Retinal fundus photograph
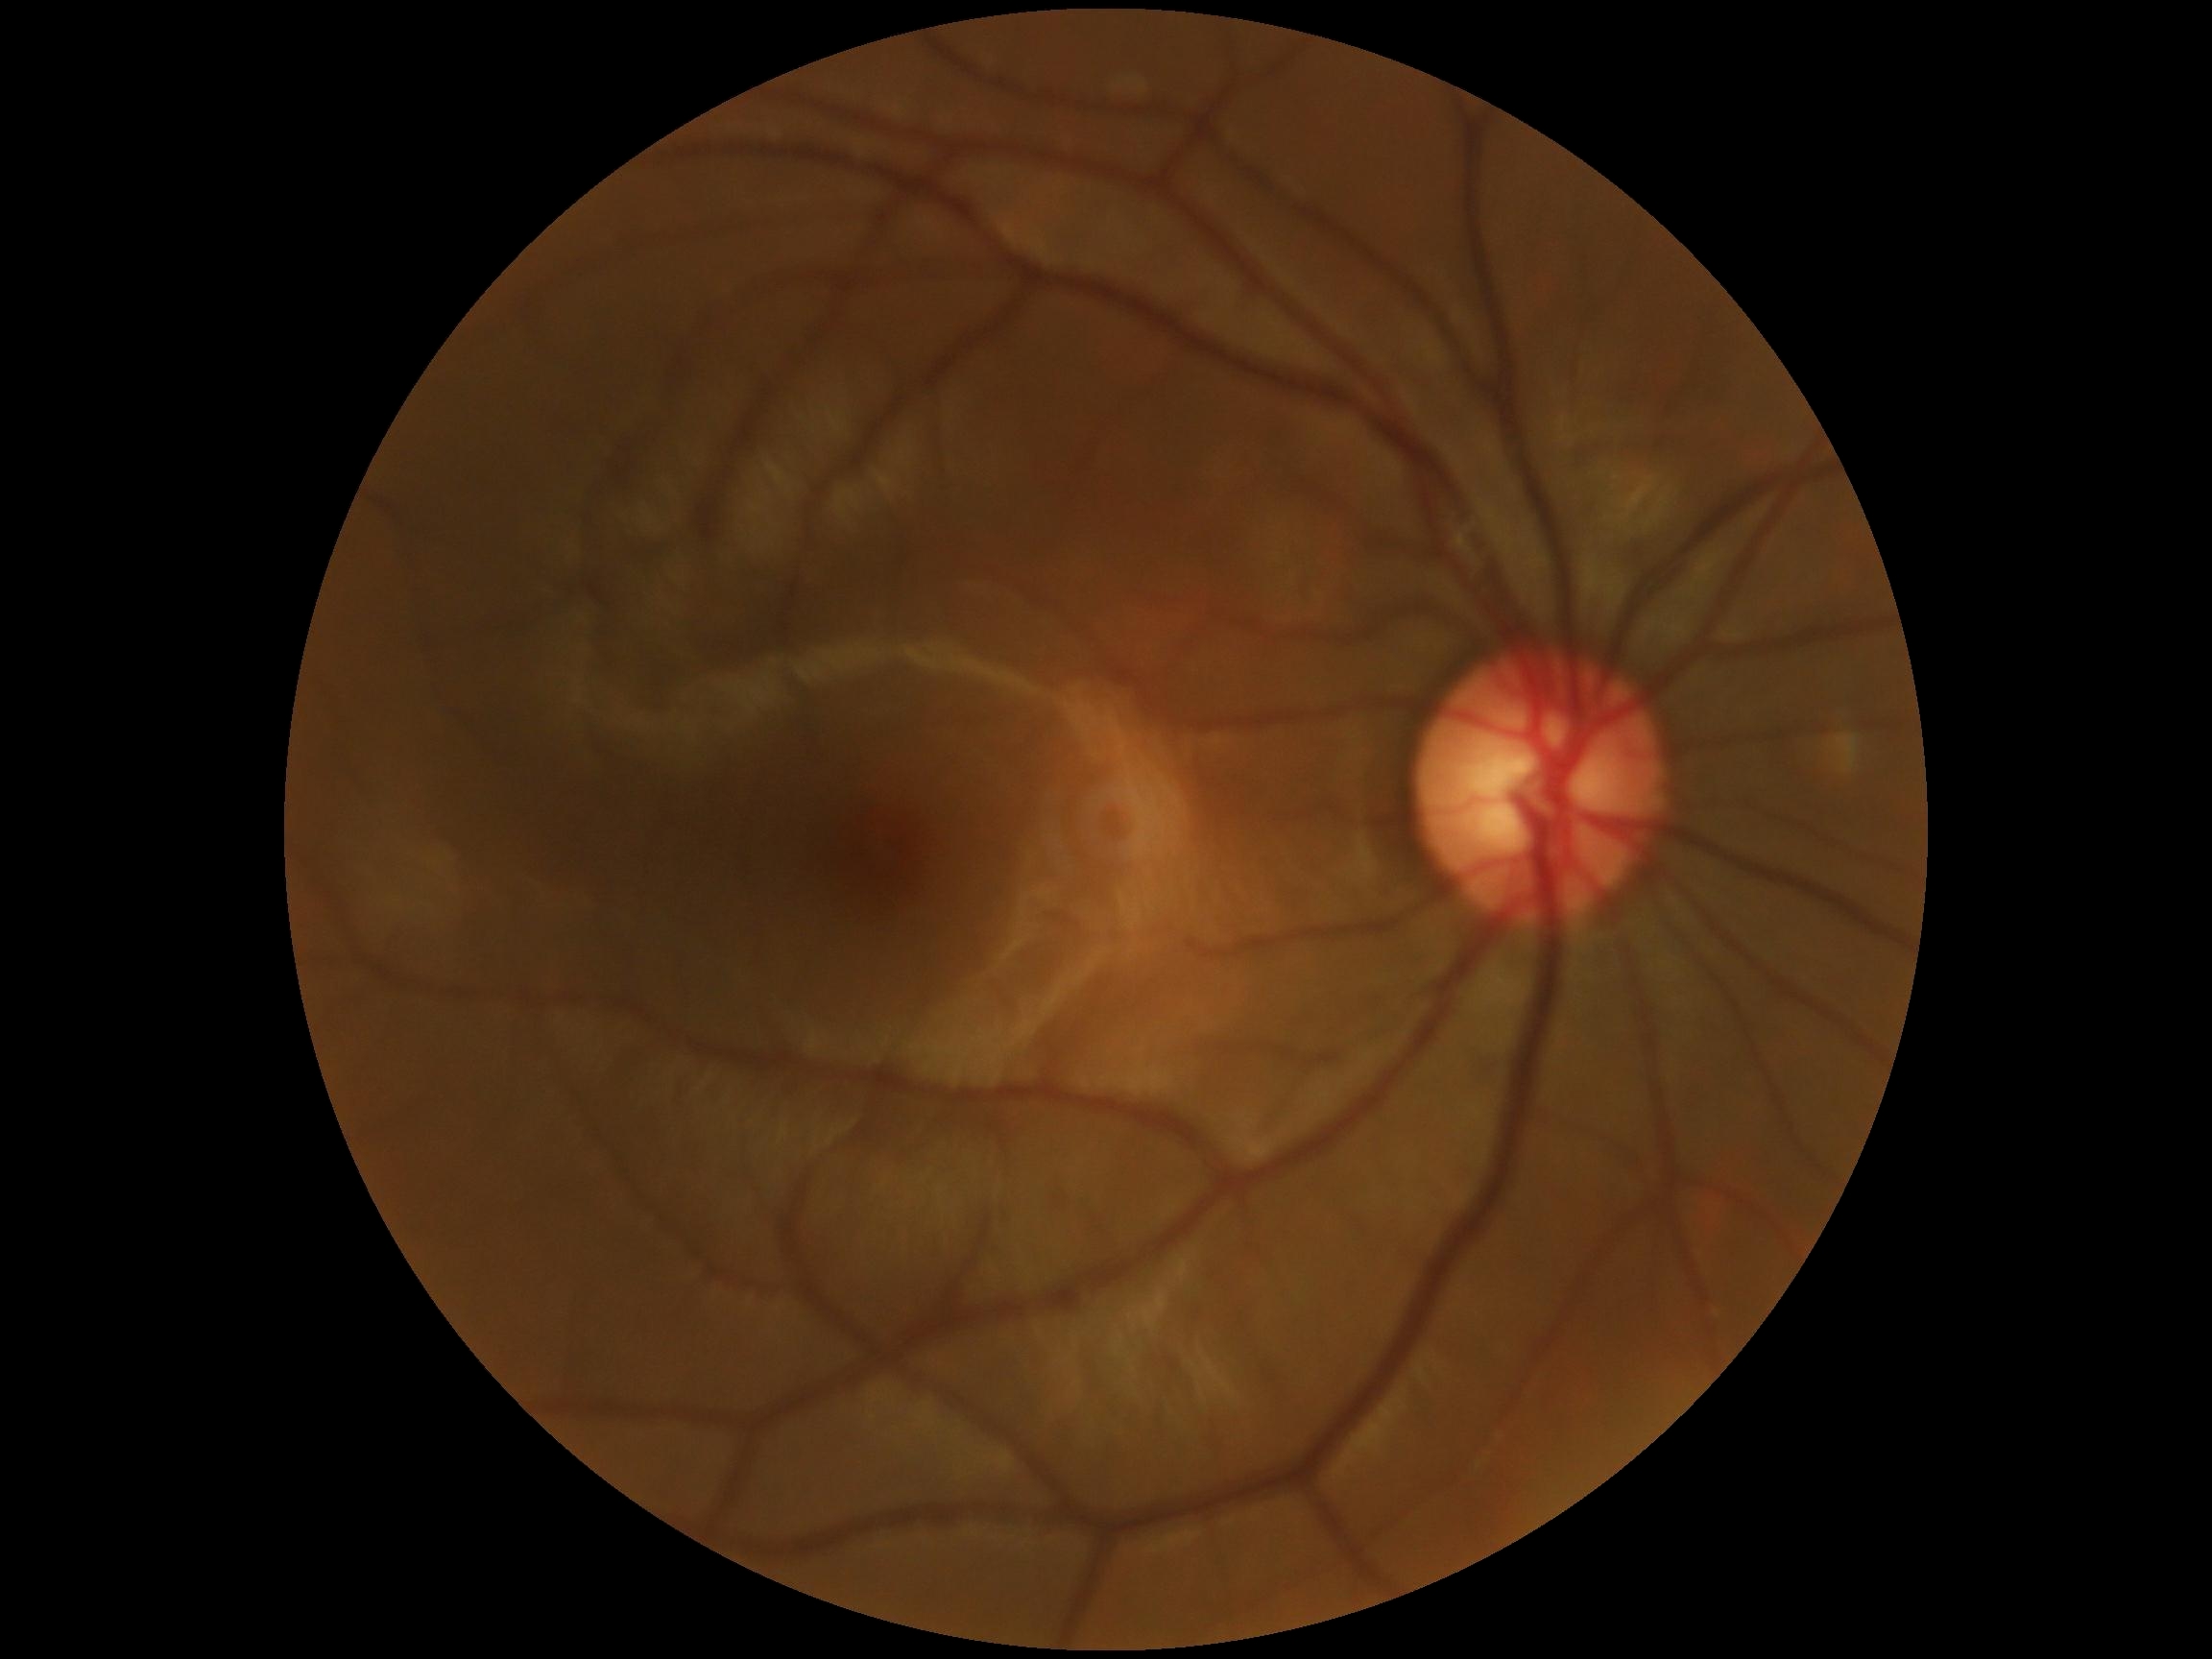
DR grade: 0.